Posterior pole color fundus photograph — 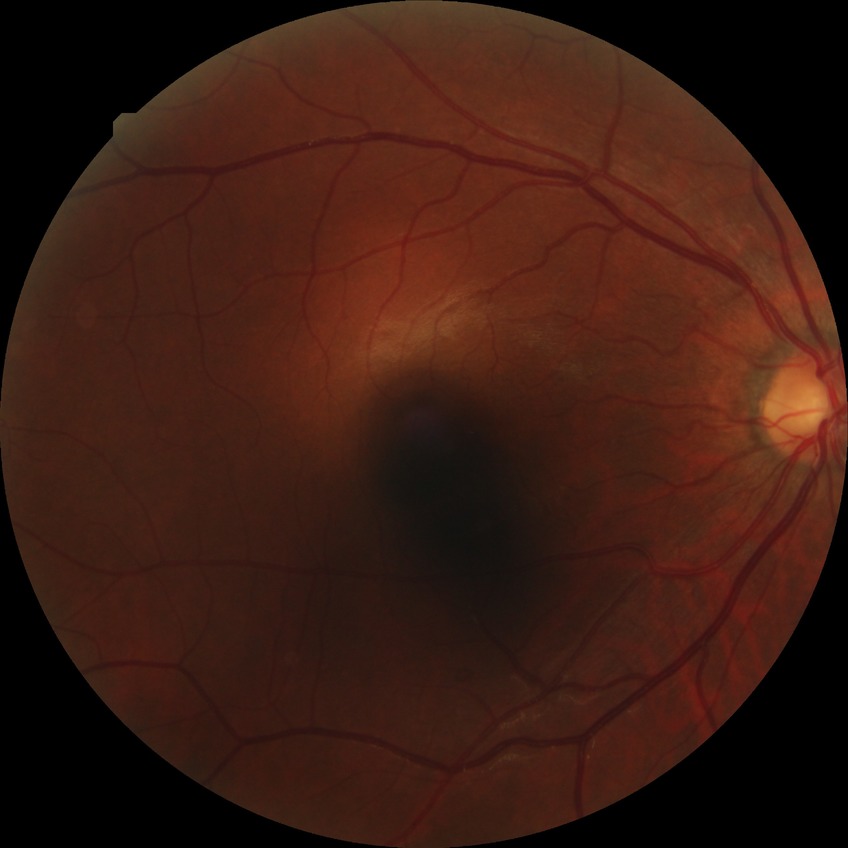 Diabetic retinopathy (DR) is simple diabetic retinopathy (SDR).